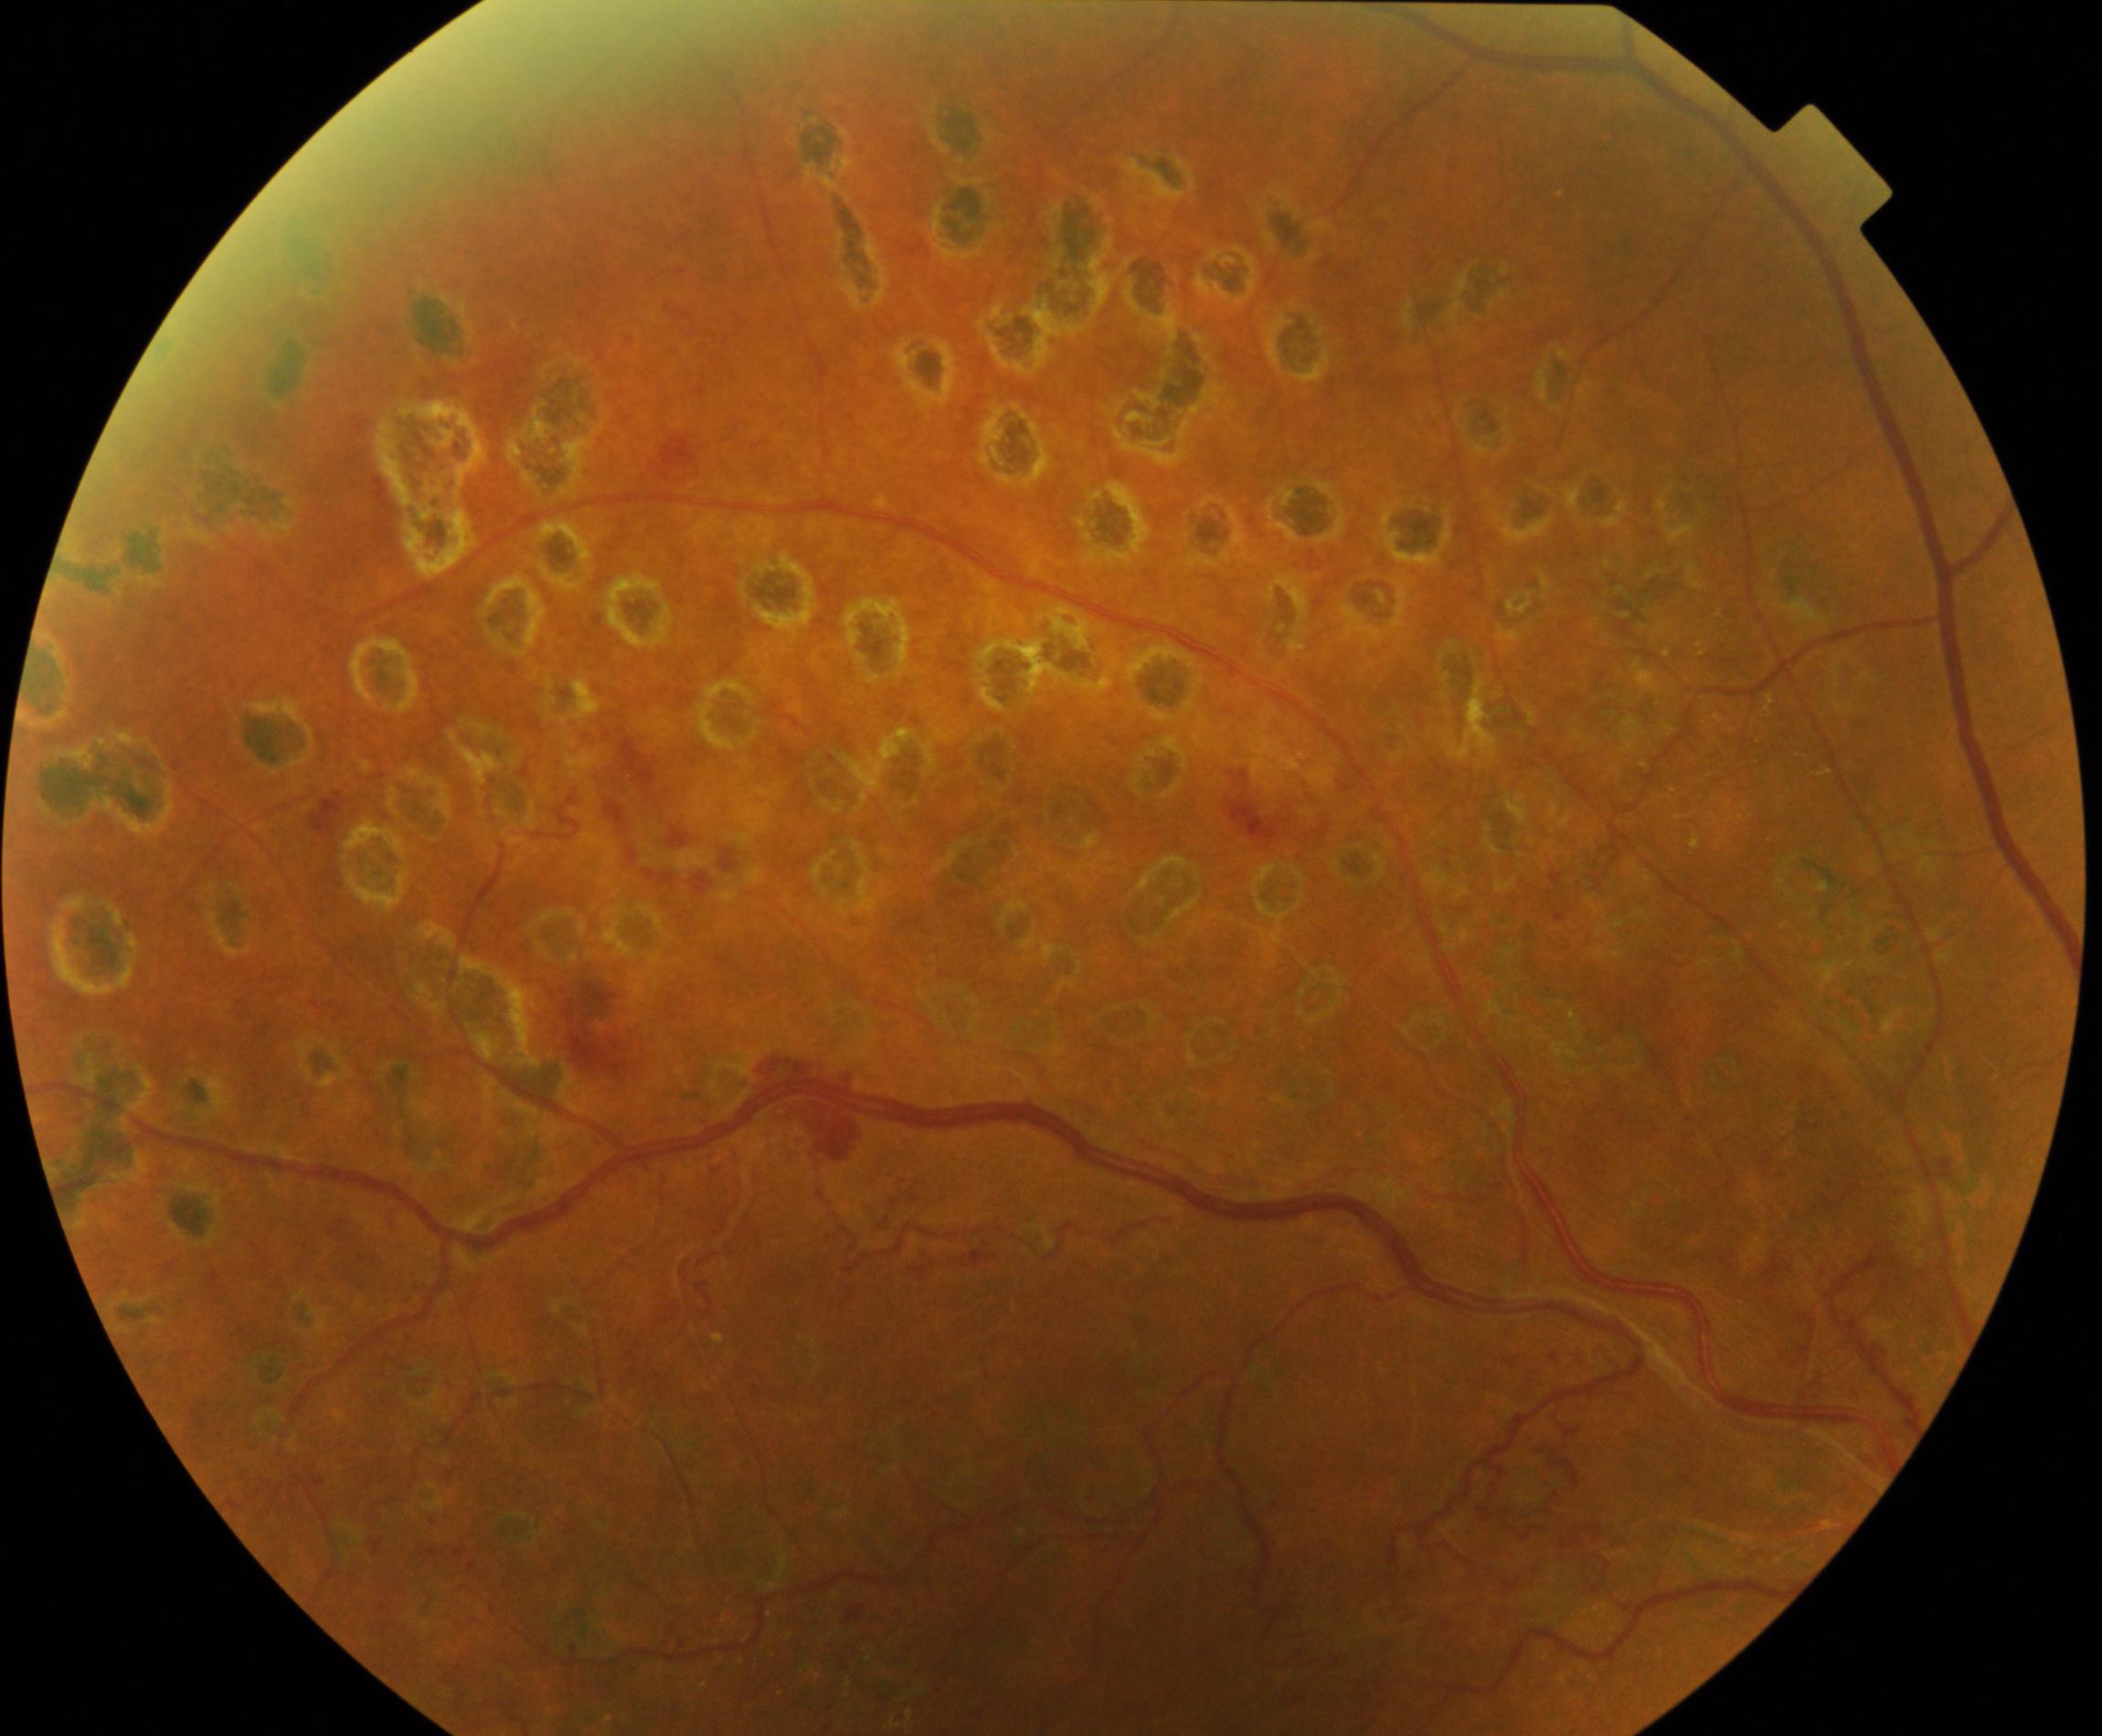 Notable finding: laser spots.